Camera: Nidek AFC-330. Image size 240x240. Fundus photo:
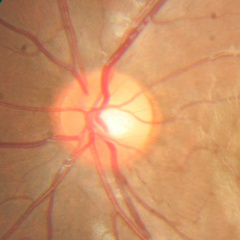 No signs of glaucoma.